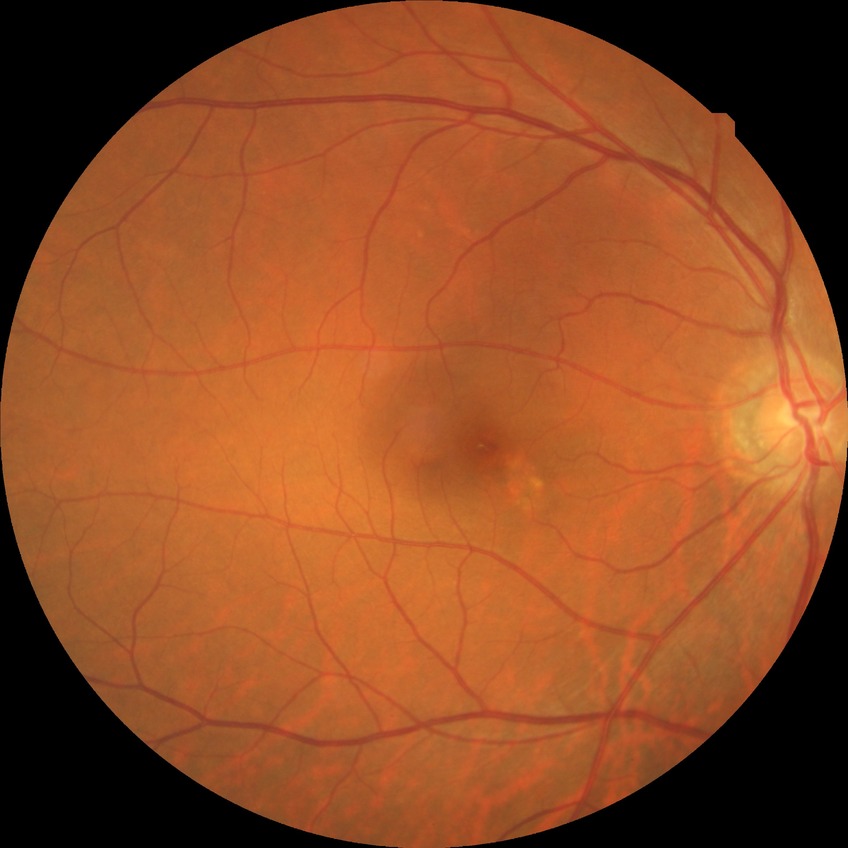

Diabetic retinopathy (DR) is no diabetic retinopathy (NDR).